Wide-field contact fundus photograph of an infant: 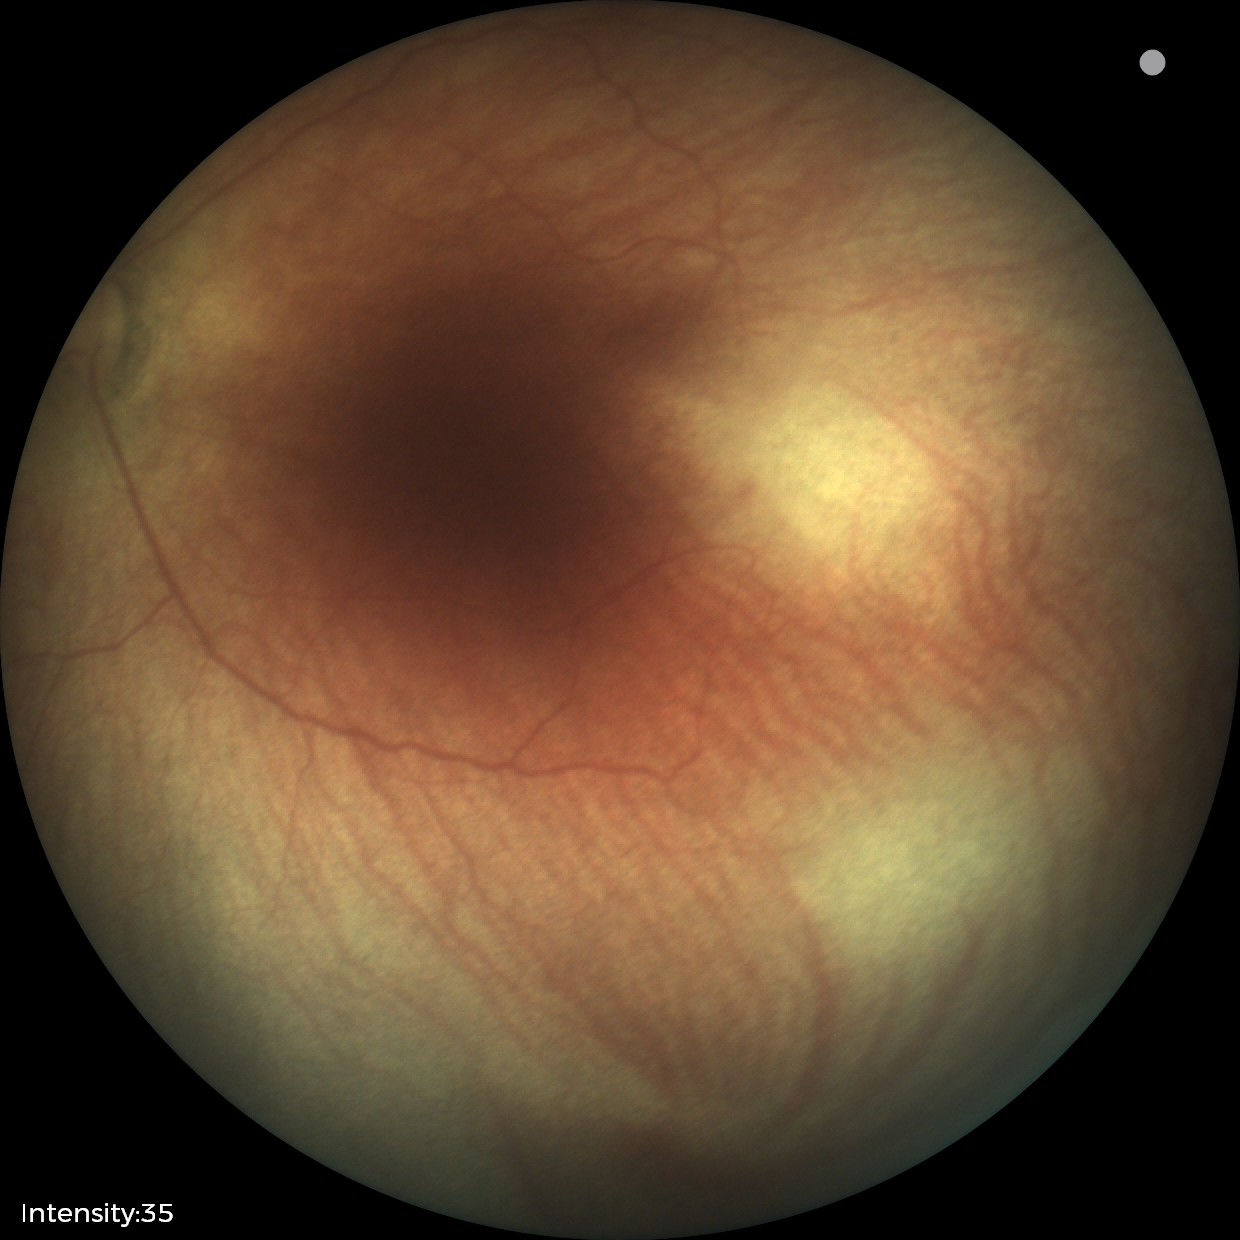
Plus disease absent.
From an examination with diagnosis of retinopathy of prematurity stage 0.